Captured without pupil dilation; intraocular pressure (IOP) (non-contact tonometry): 22 mmHg; refractive error: +1 -1.5 x 95; 30° field of view — 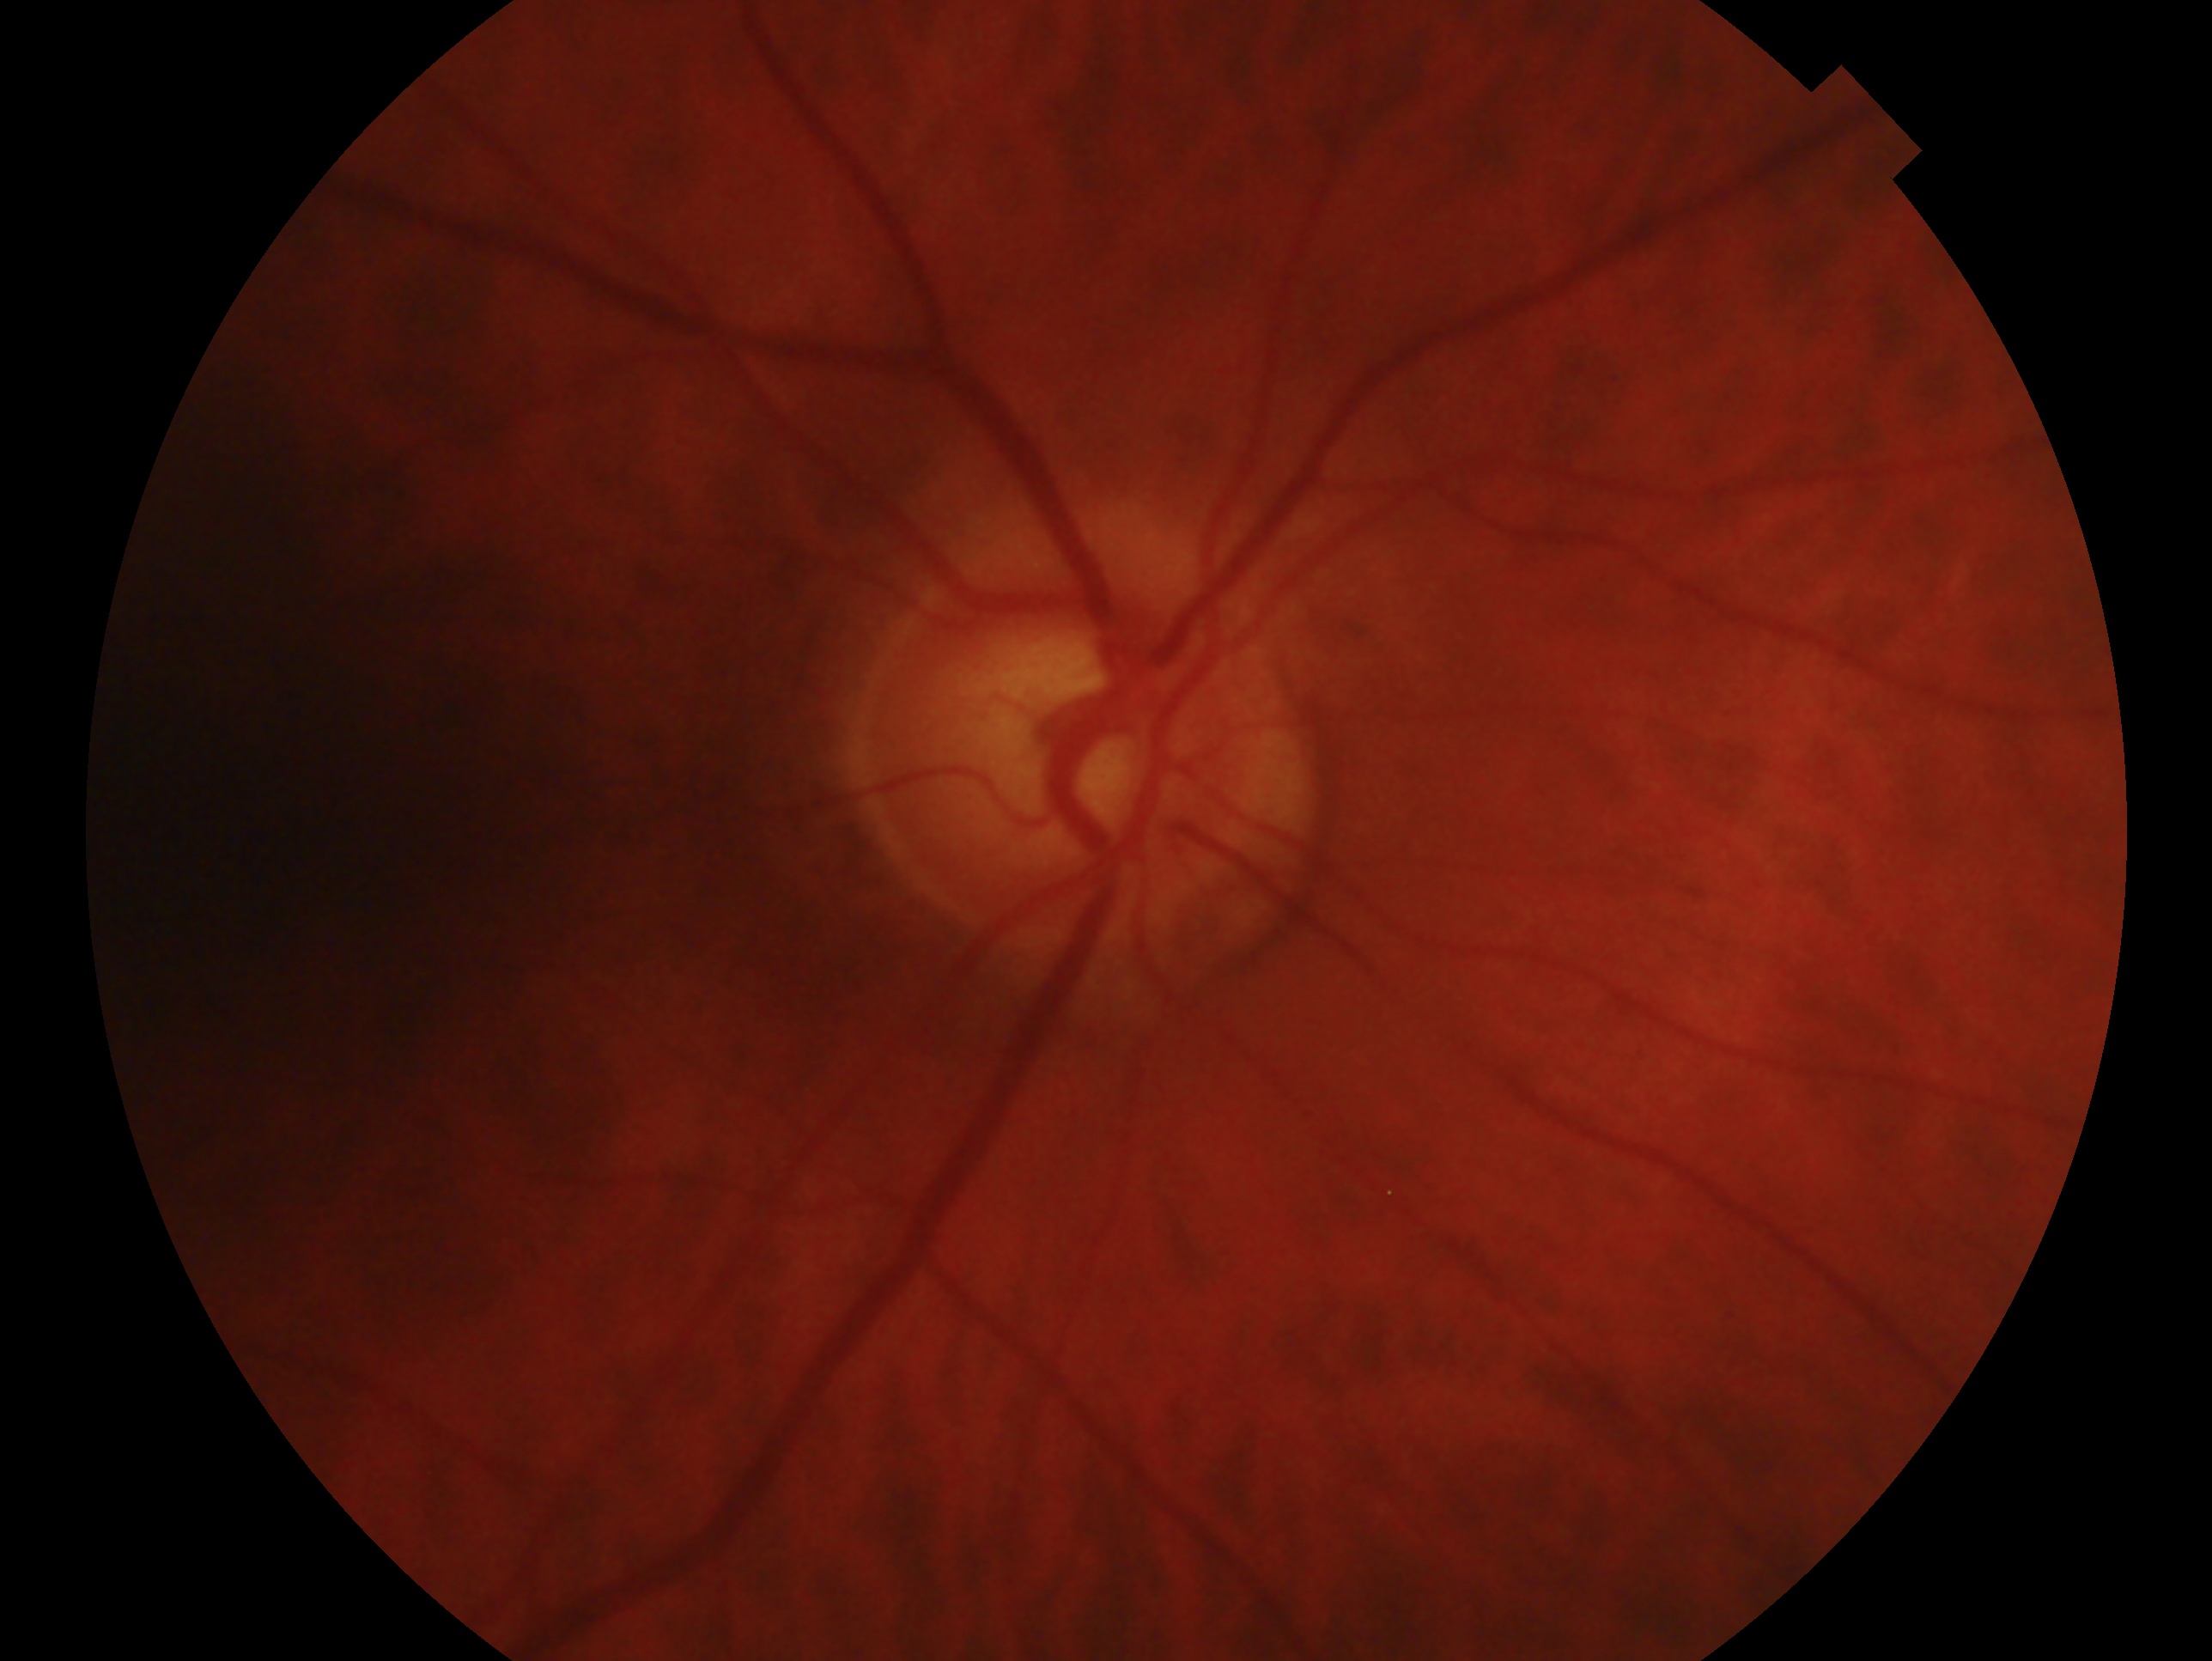
Annotations:
– glaucoma diagnosis: suspicious for glaucoma
– laterality: right eye